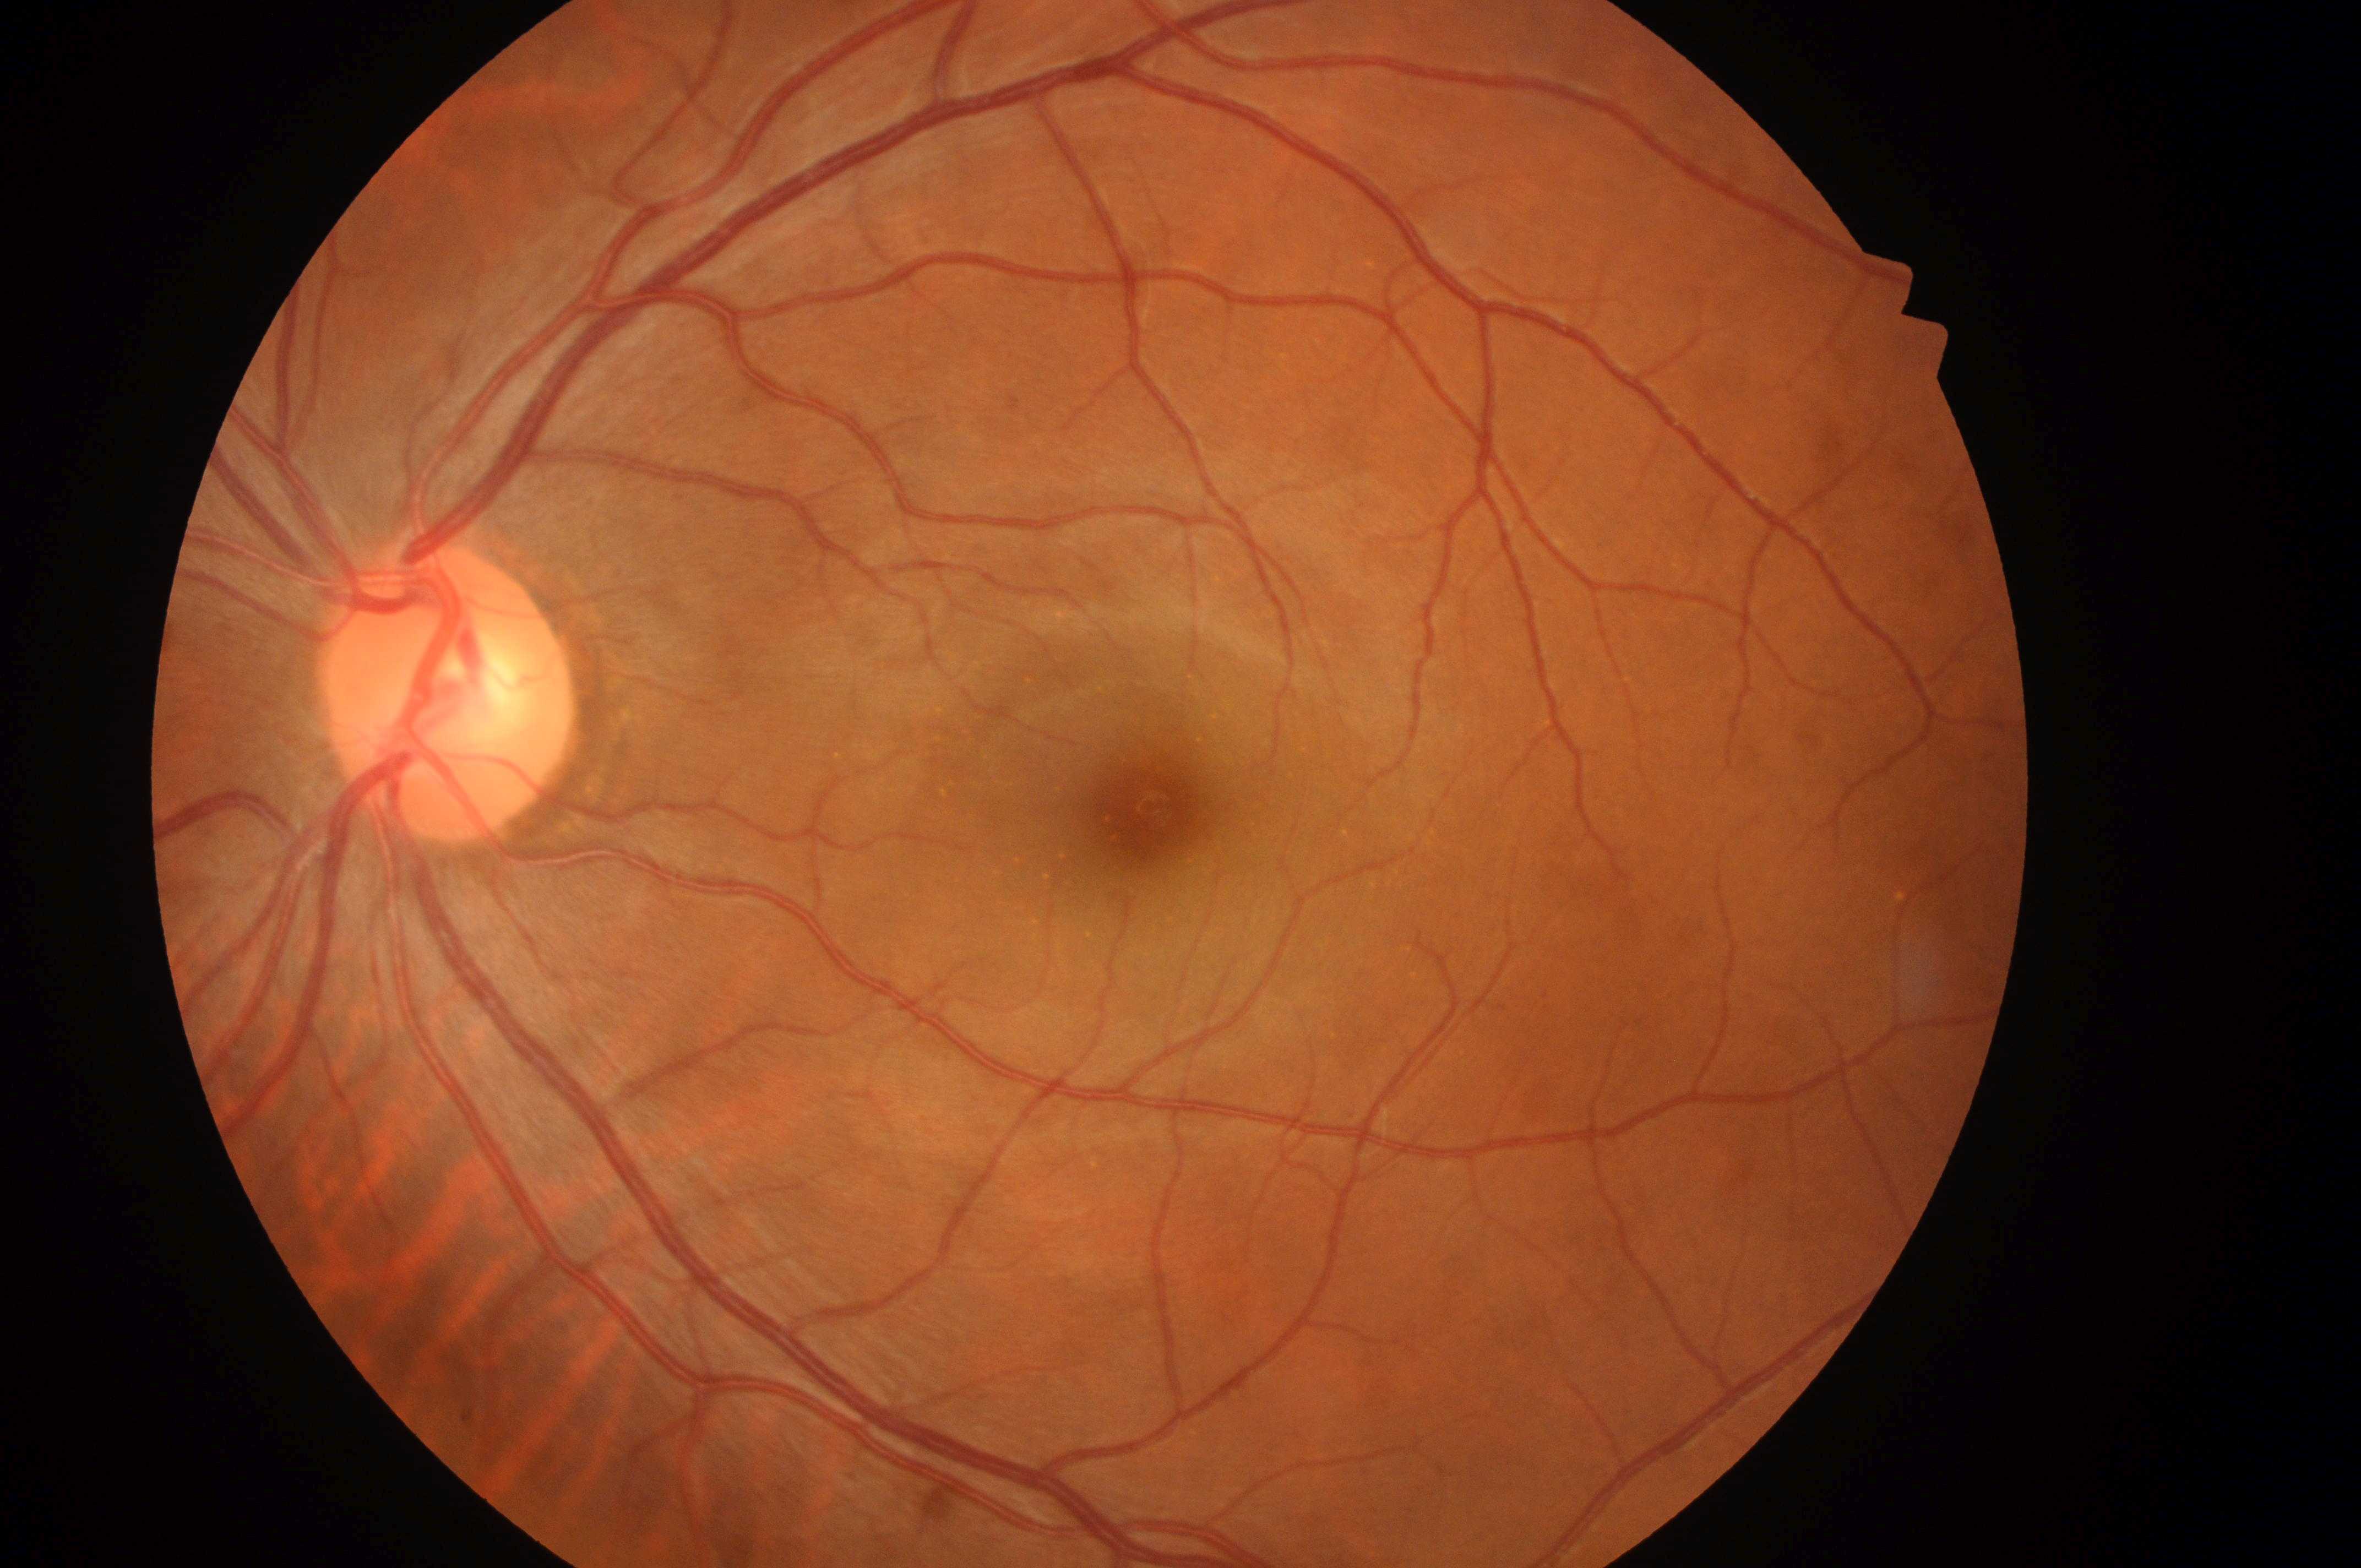 Q: Locate the fovea.
A: [1147, 806]
Q: Macular edema risk?
A: grade 0 (no risk)
Q: What is the DR grade?
A: no apparent retinopathy (0)
Q: Where is the optic disc?
A: [441, 703]
Q: Right or left eye?
A: OS
Q: Is there DR or DME?
A: No apparent diabetic retinopathy or macular edema